45° field of view · color fundus photograph · nonmydriatic fundus photograph · image size 848x848:
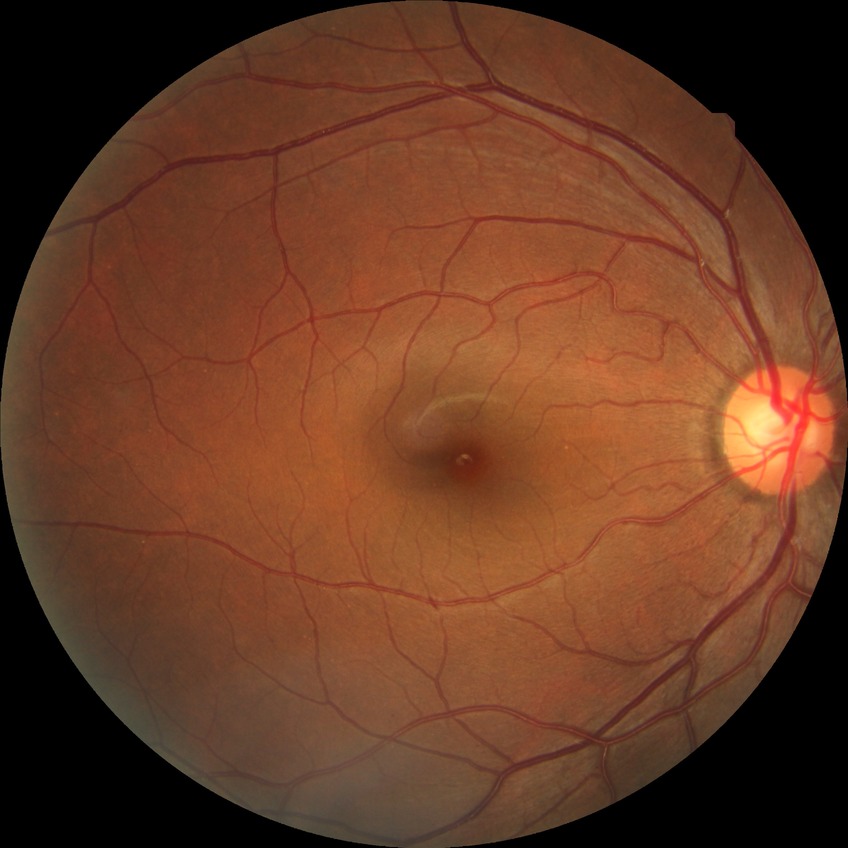   davis_grade: no diabetic retinopathy